Retinal fundus photograph. FOV: 45 degrees. 2352x1568
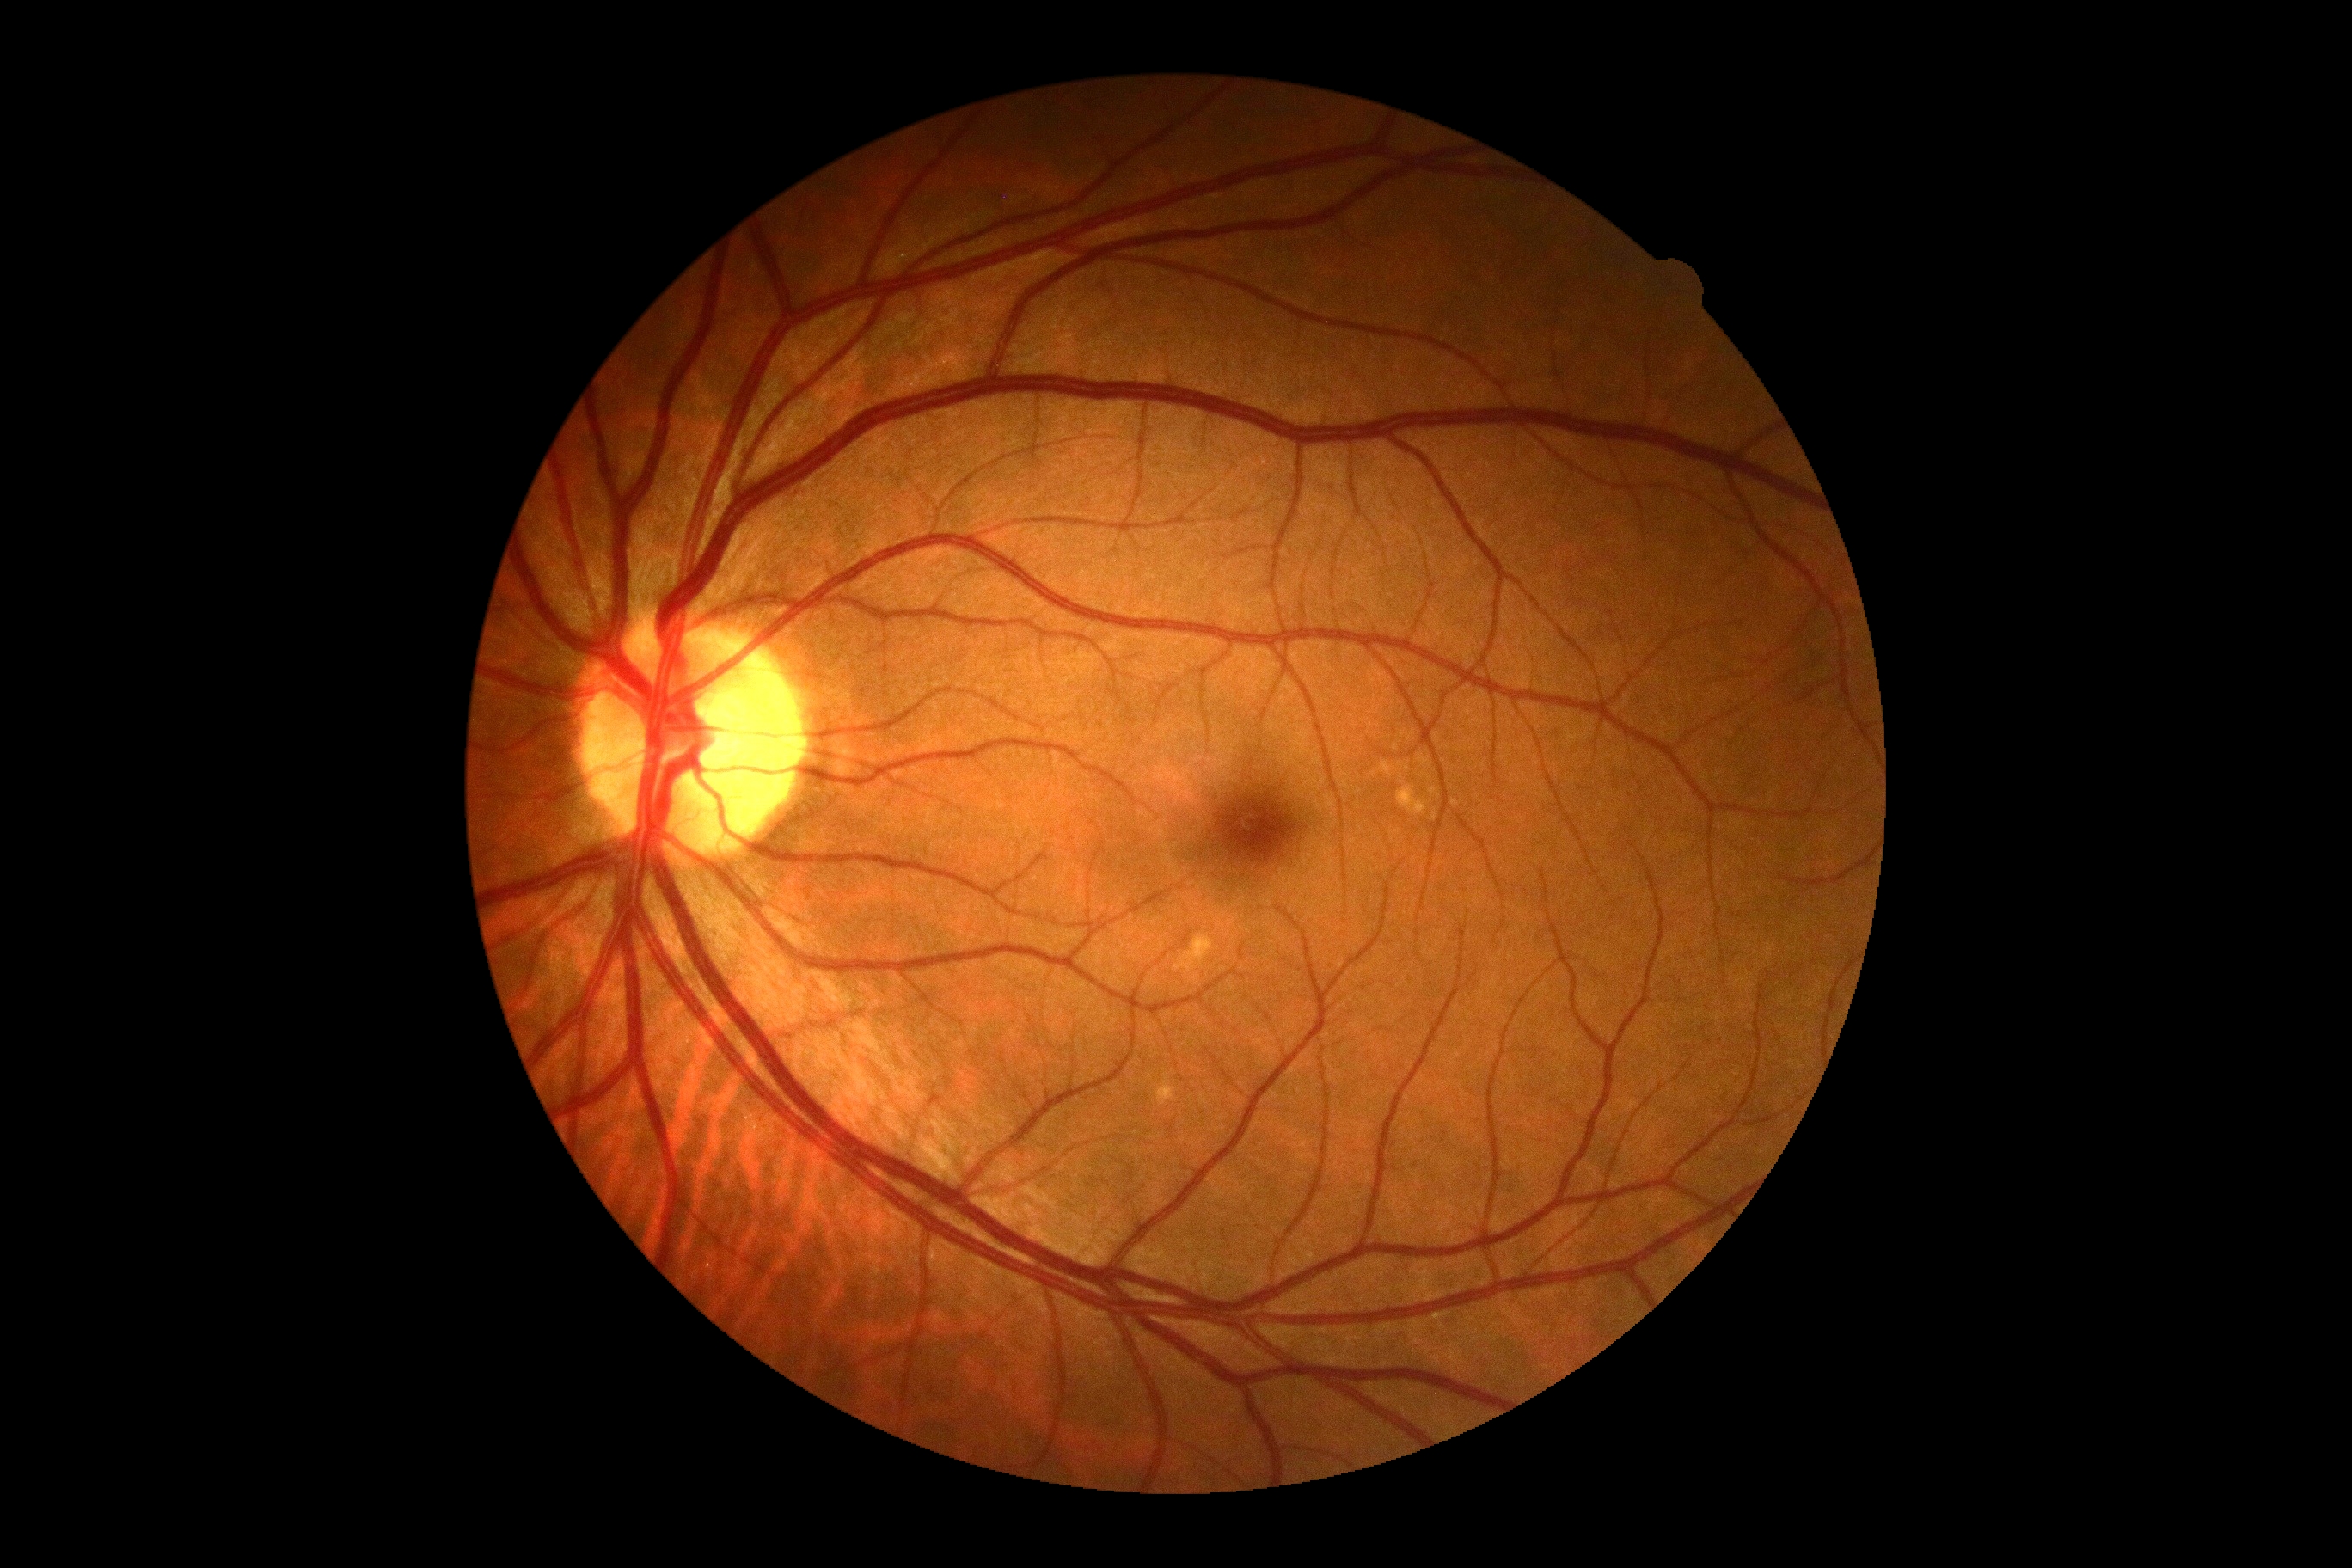 {"dr_grade": "0", "dr_impression": "no apparent DR"}